Retinal fundus photograph.
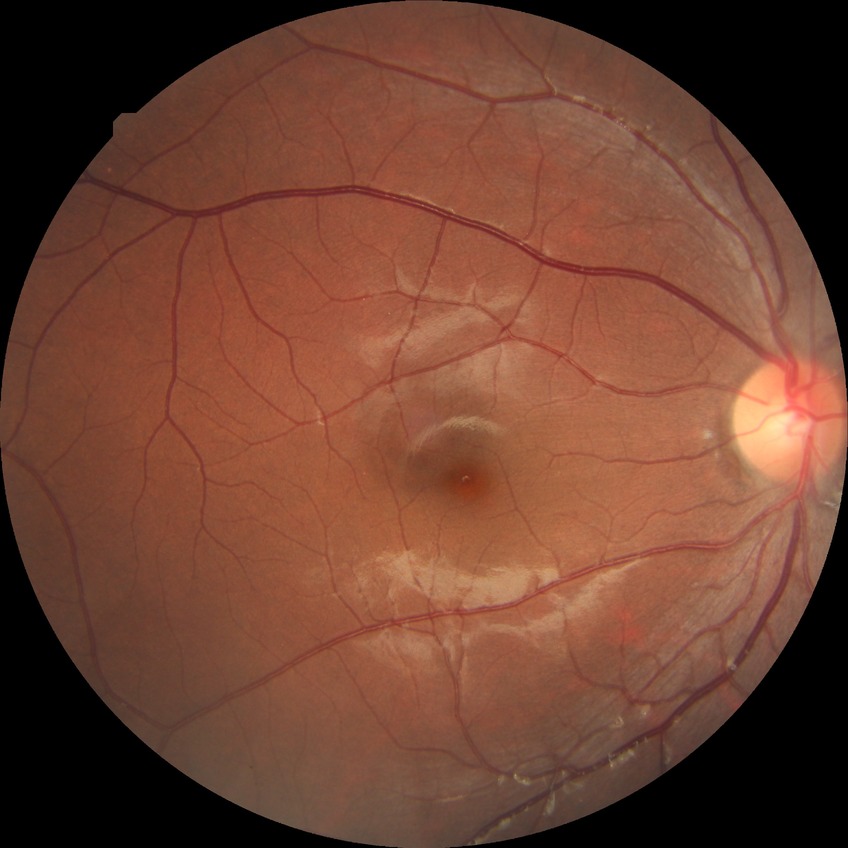

Diabetic retinopathy grade is no diabetic retinopathy.